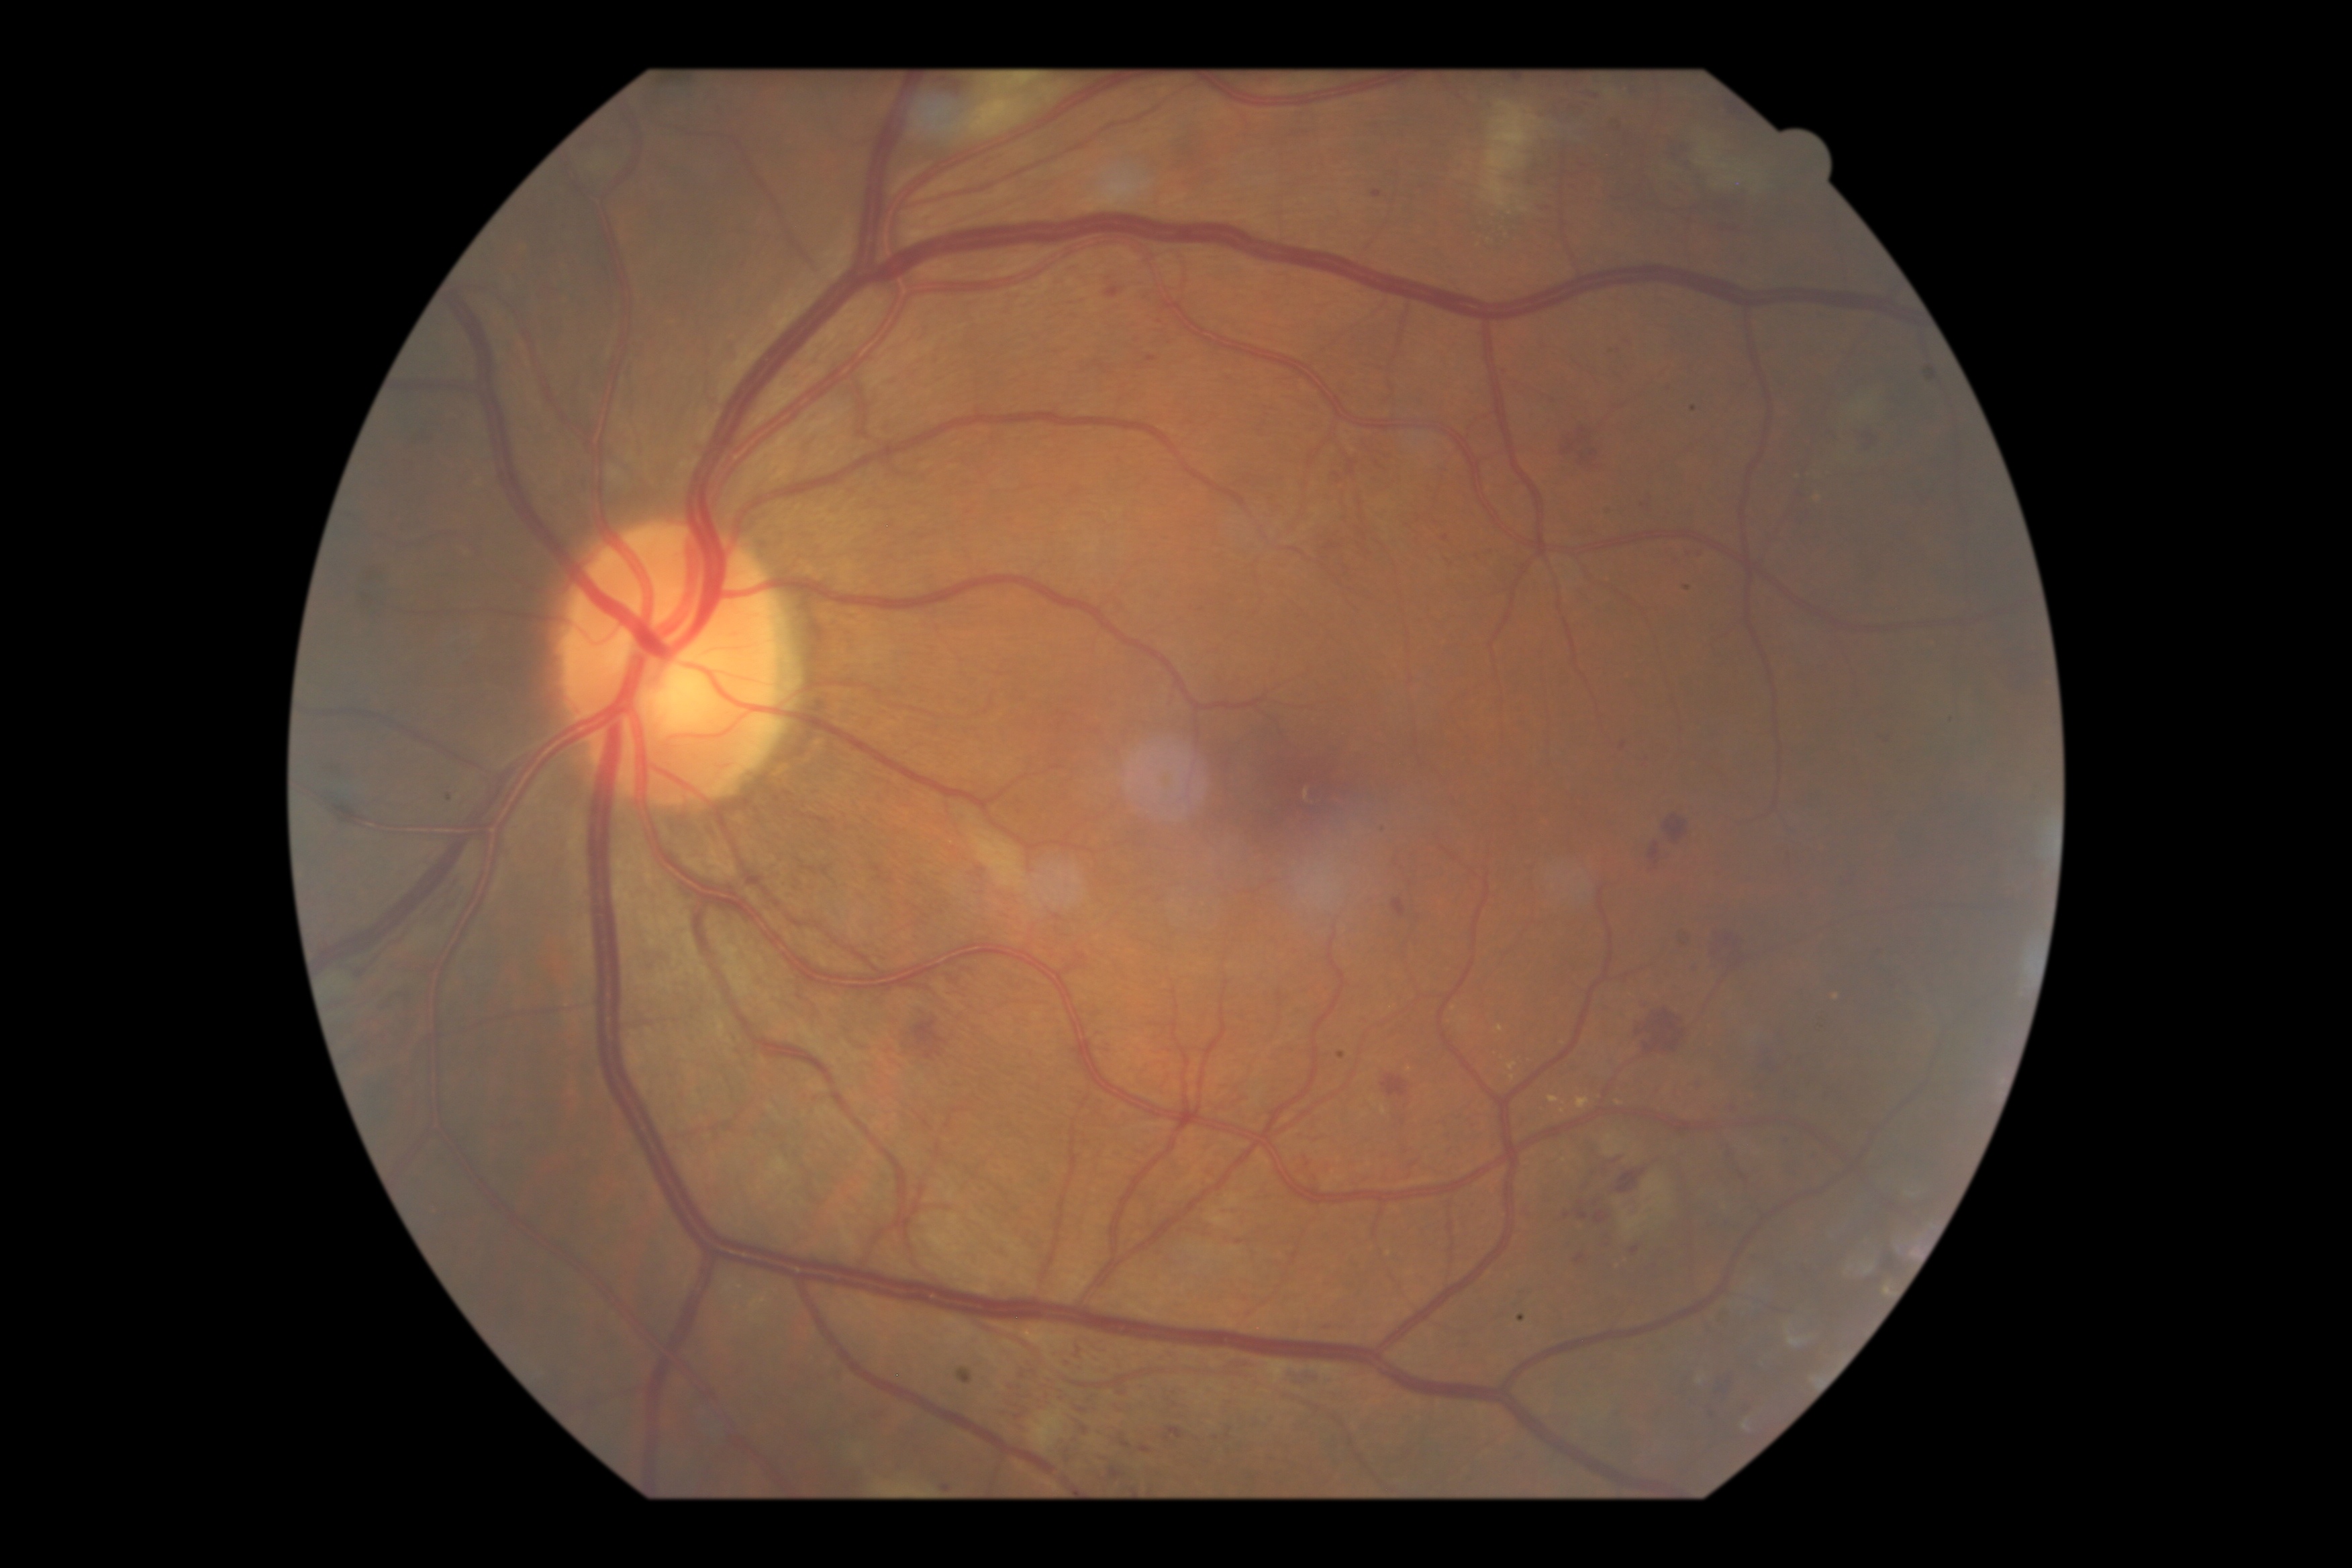 Diabetic retinopathy grade: 2 (moderate NPDR).